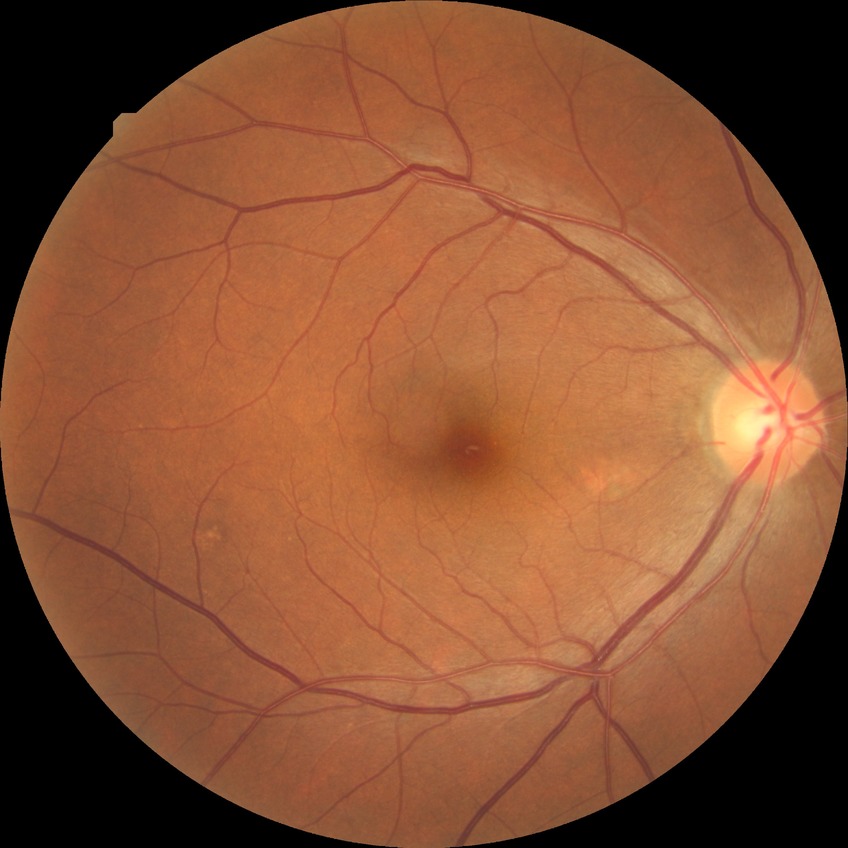 Findings:
* diabetic retinopathy grade — no diabetic retinopathy